1960x1897; 45-degree field of view:
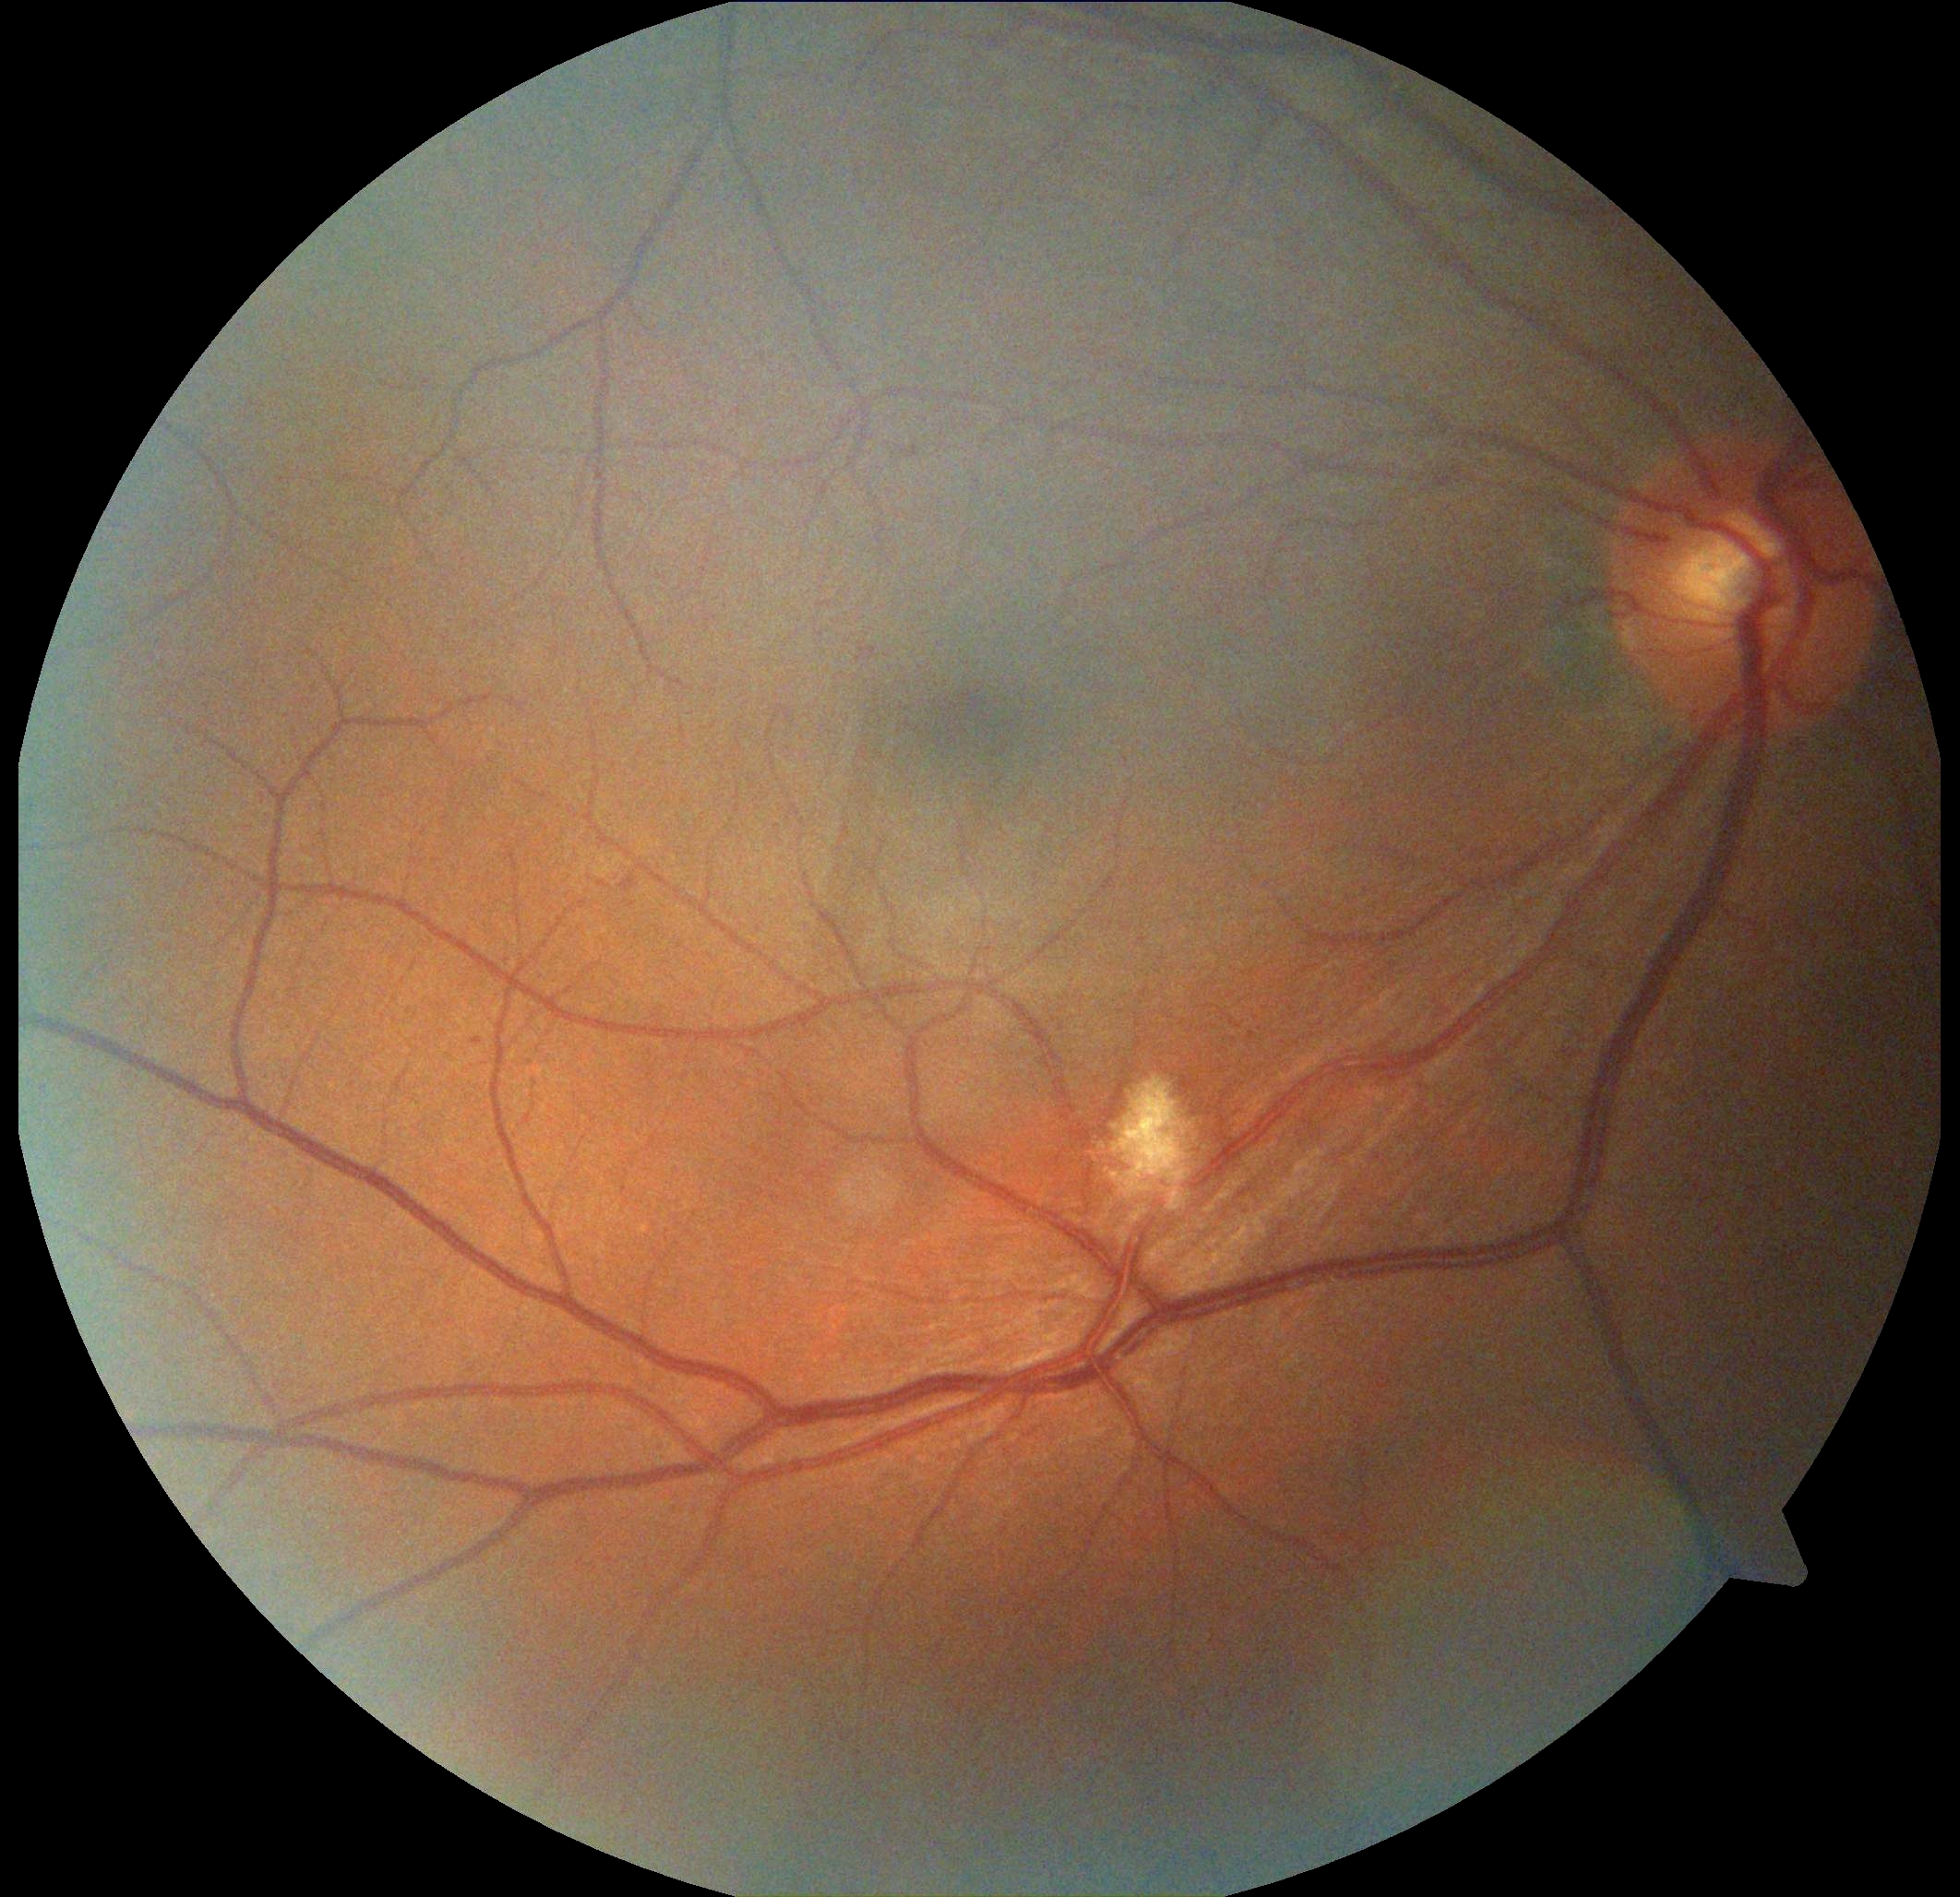
DR is 2.